Color fundus photograph
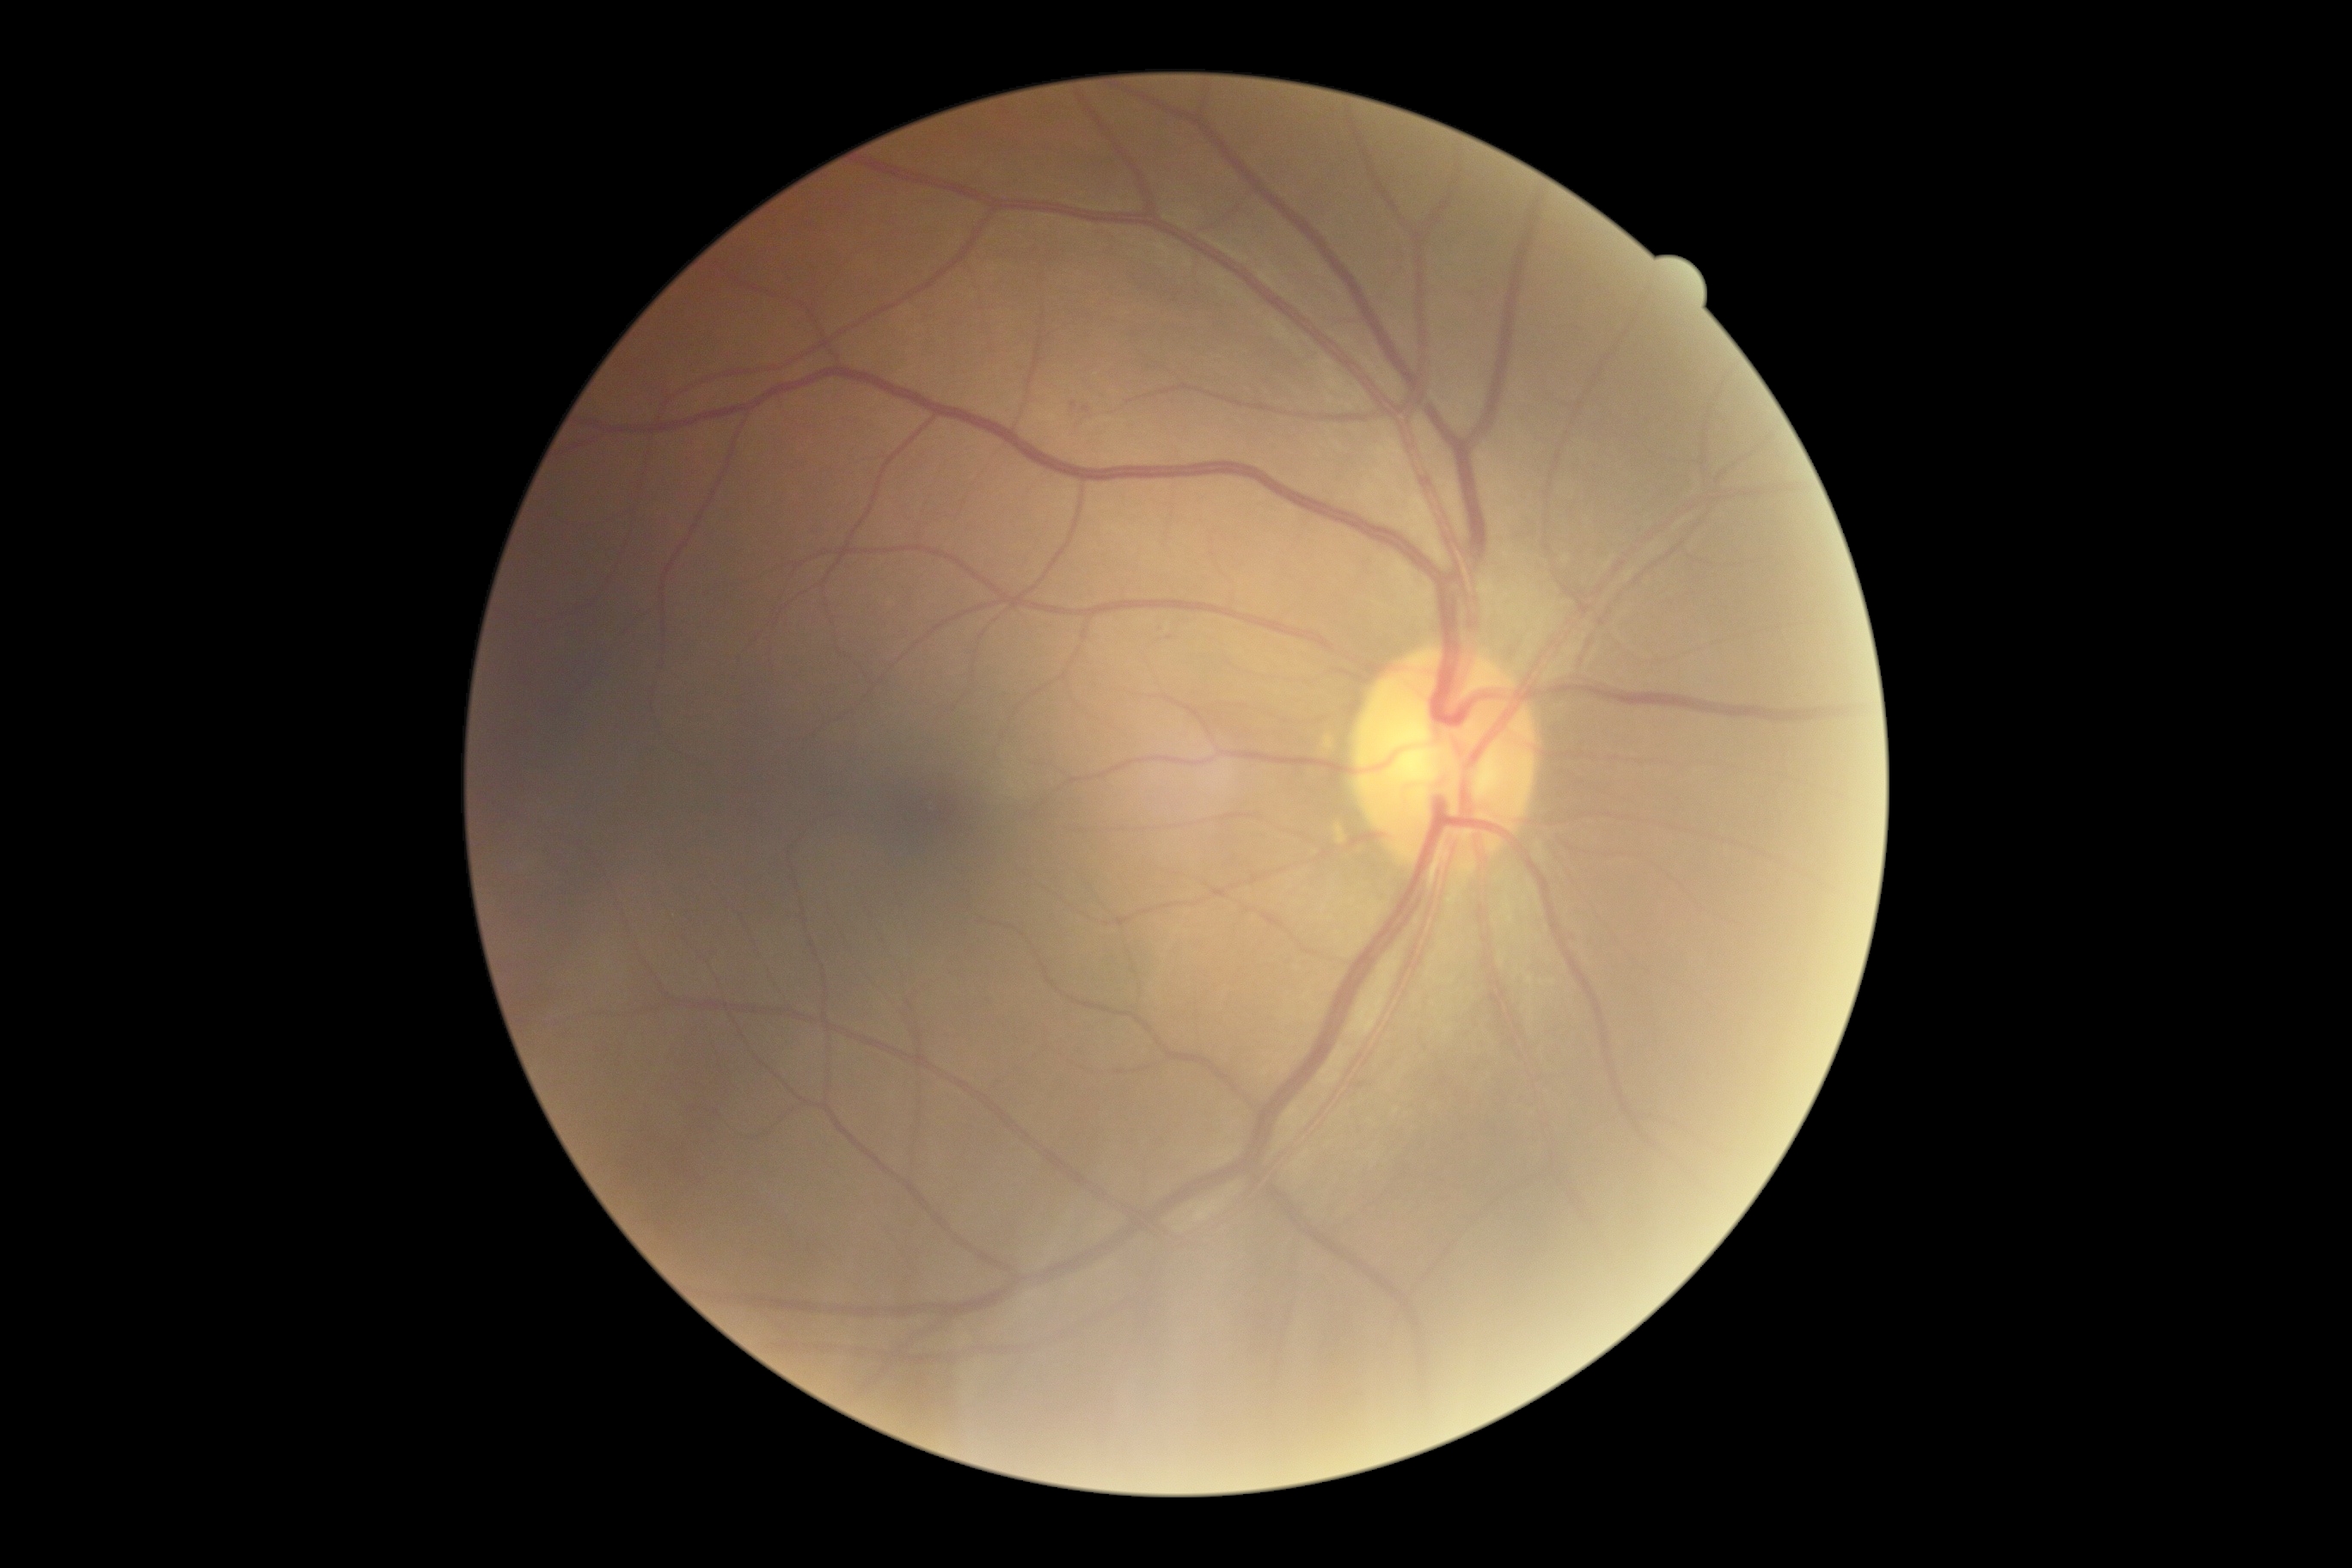 retinopathy grade: mild NPDR (1)